Wide-field fundus photograph of an infant. Image size 1240x1240:
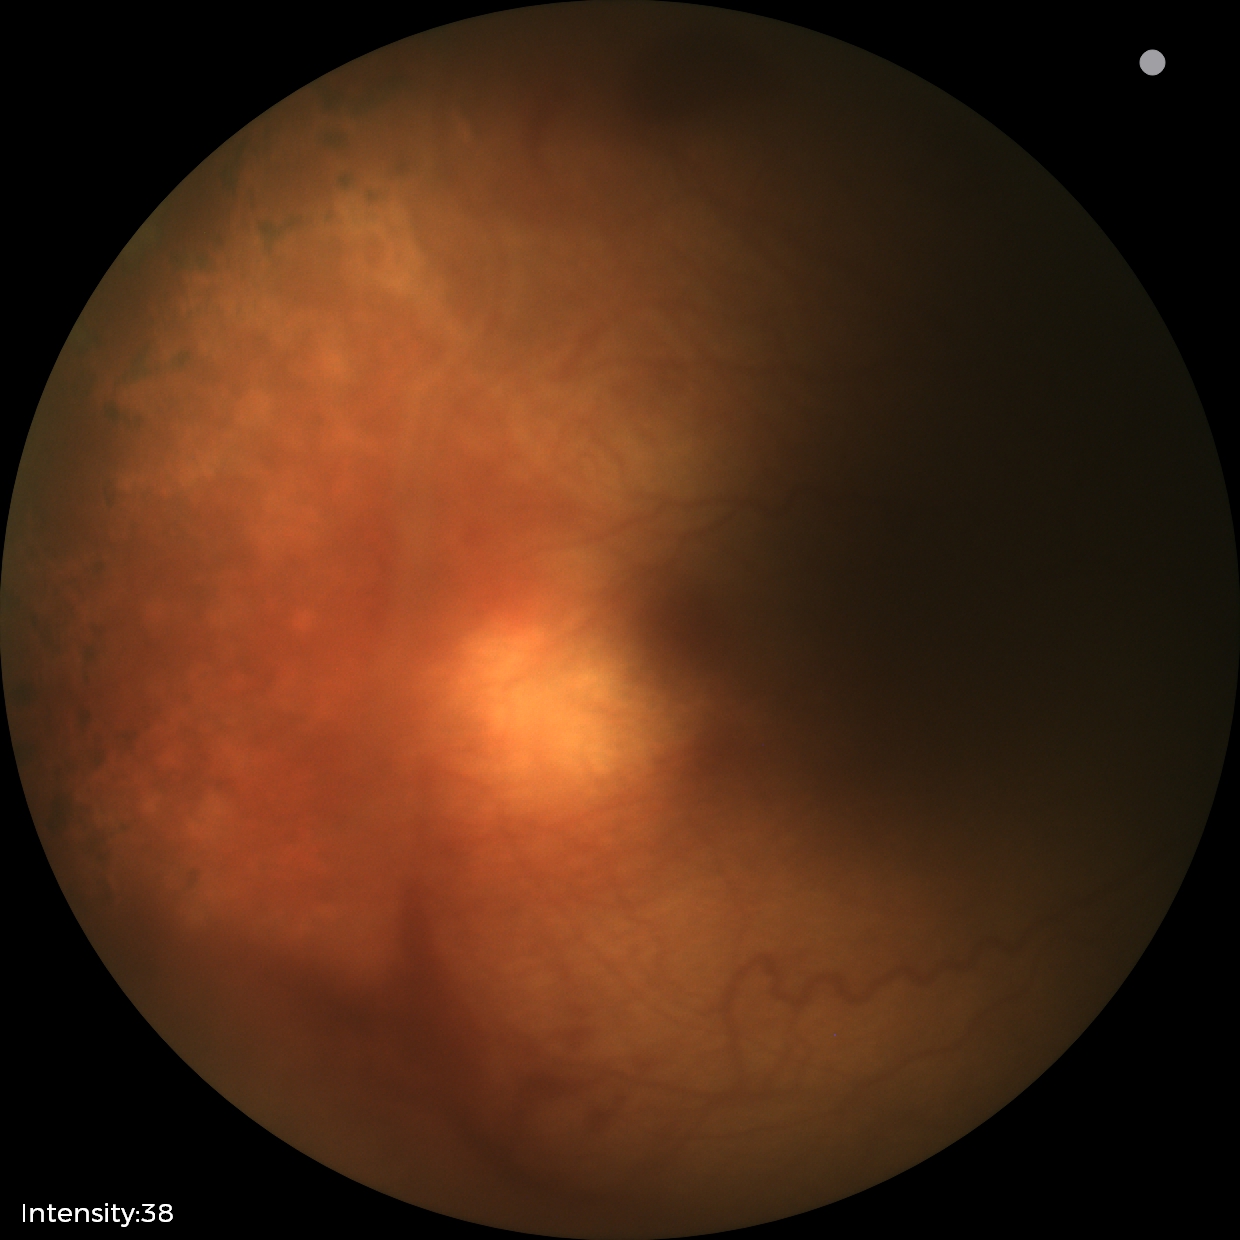
Examination diagnosed as status post retinopathy of prematurity — retinal appearance after treated retinopathy of prematurity.
Plus disease absent.